640x480px; pediatric retinal photograph (wide-field):
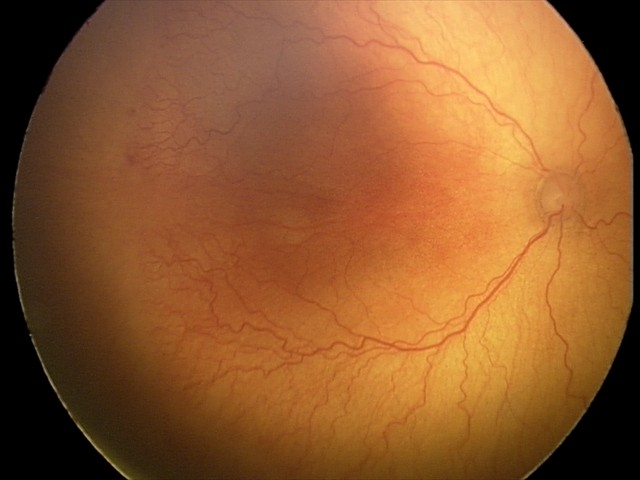

Plus disease present. Diagnosis from this screening exam: aggressive retinopathy of prematurity (A-ROP).